45° field of view, 2352x1568, fundus photo
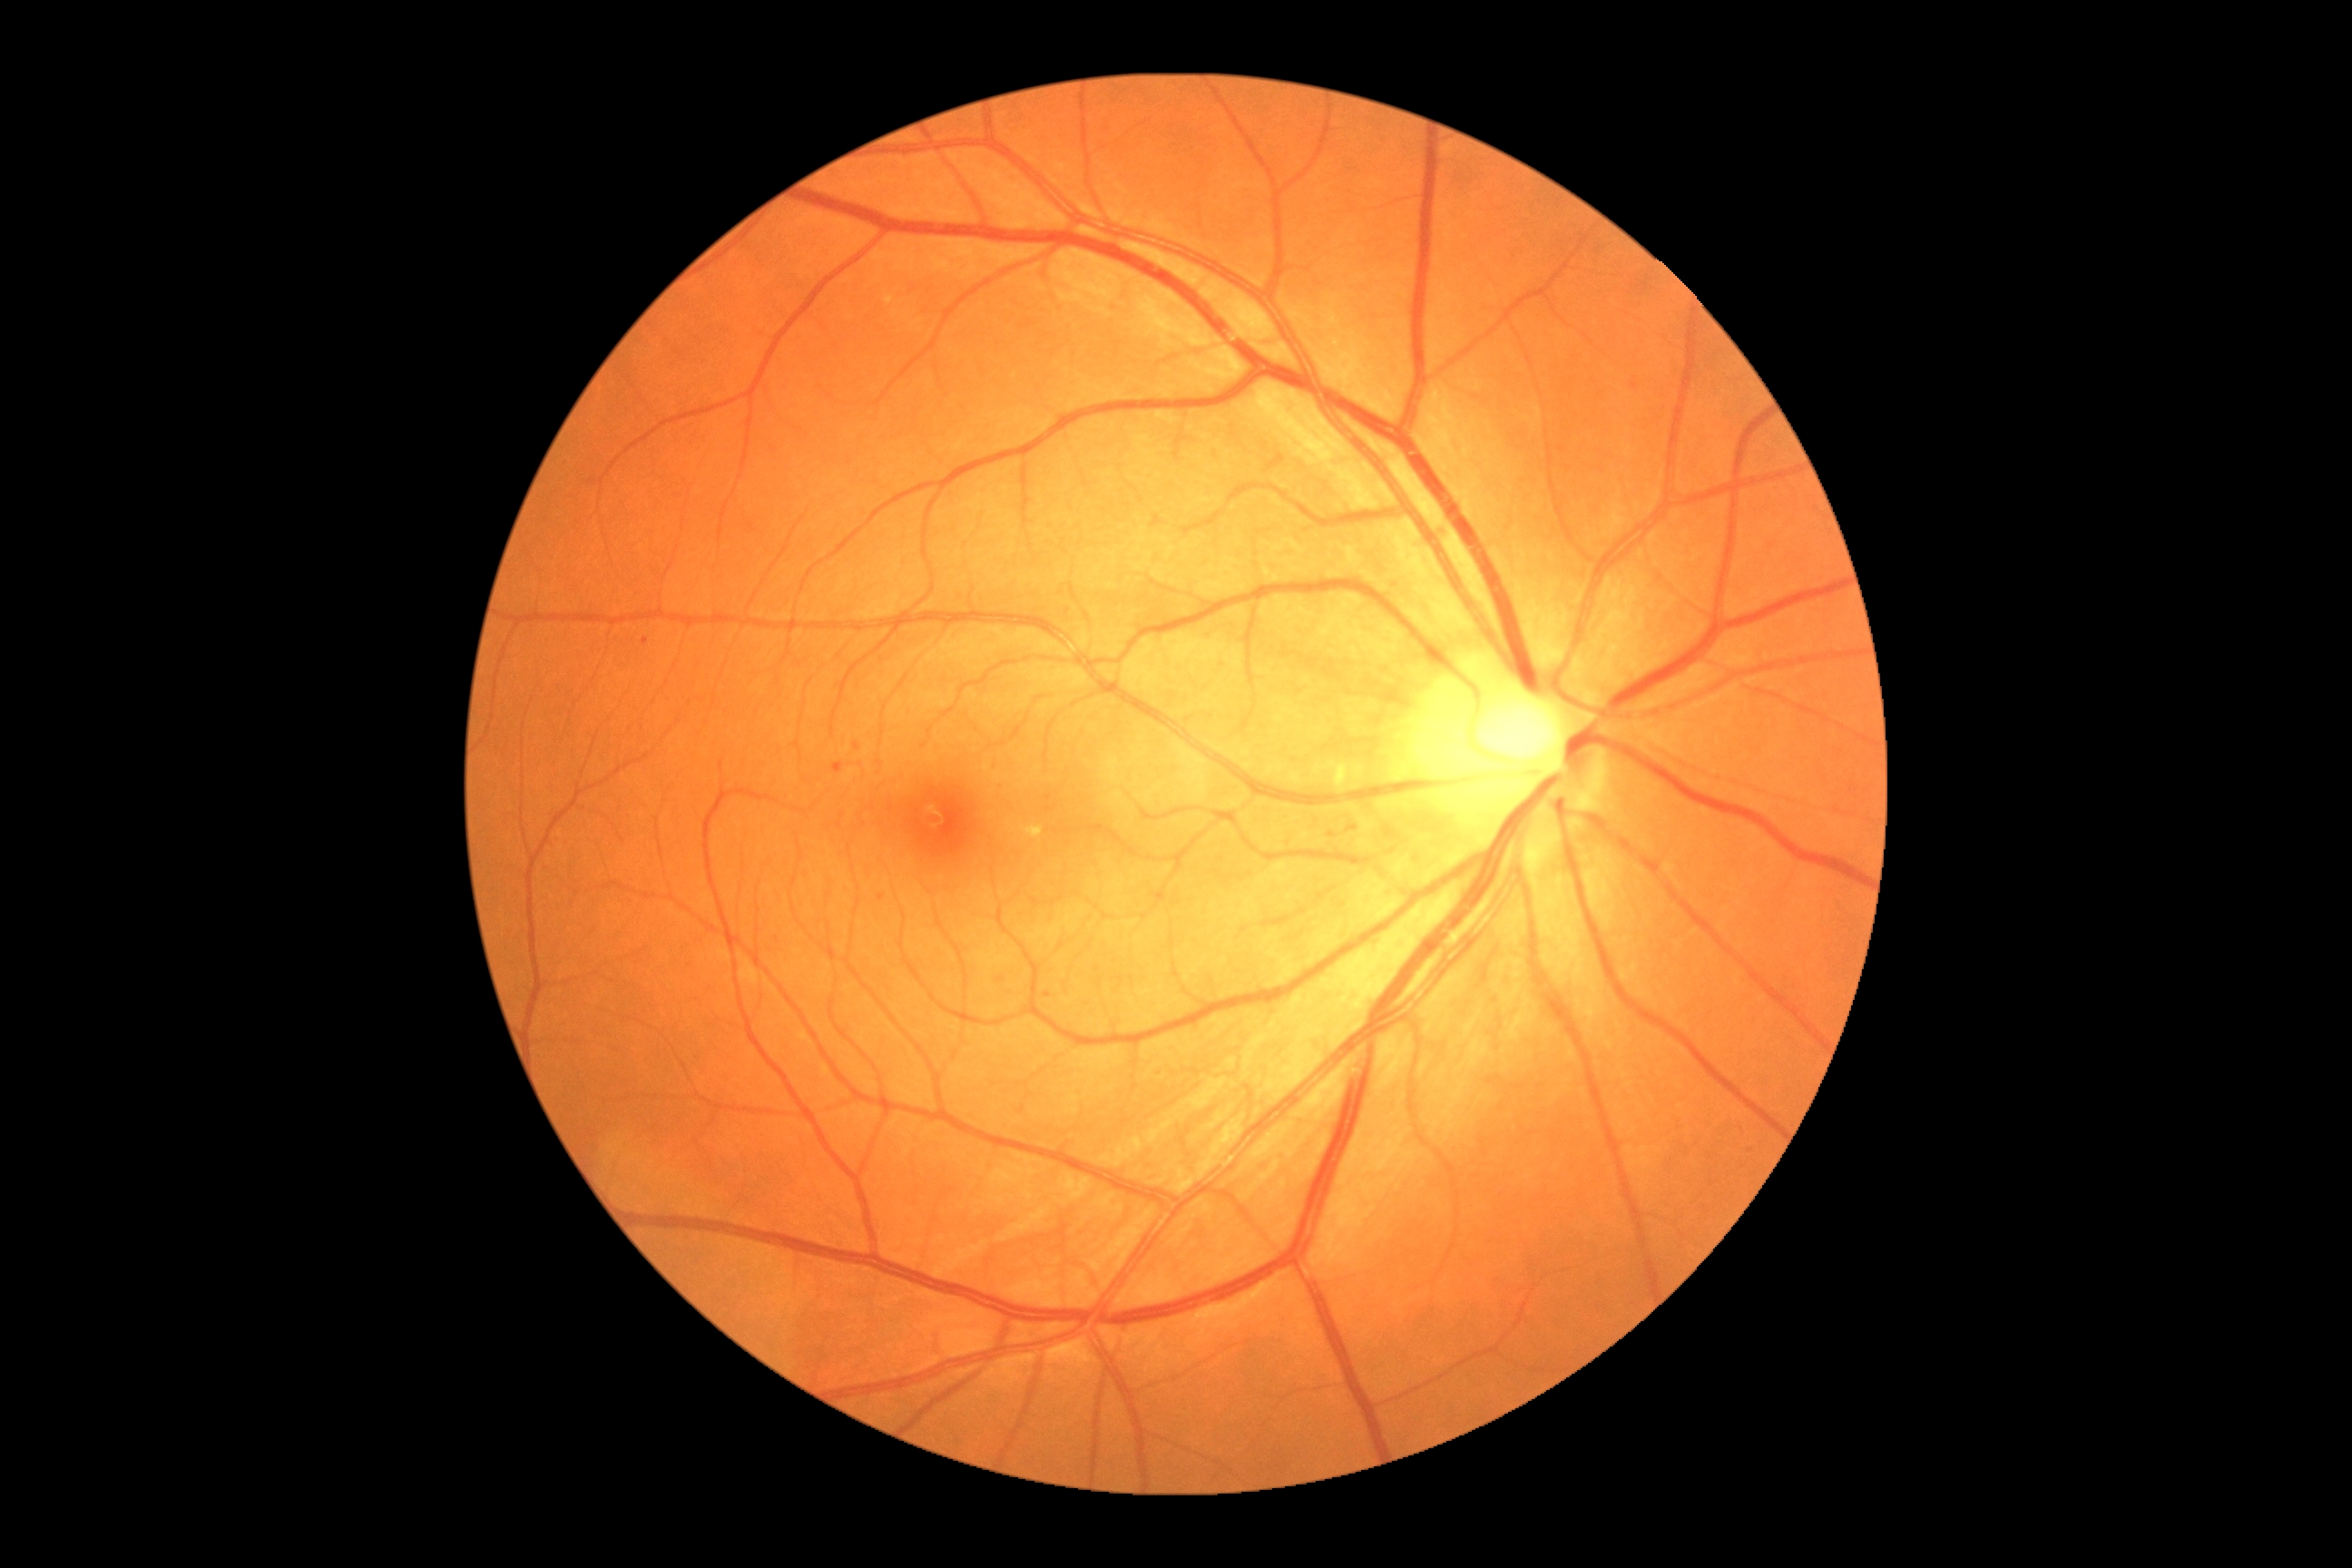
{
  "dr_grade": "moderate NPDR (grade 2)",
  "dr_category": "non-proliferative diabetic retinopathy"
}